640 x 480 pixels; wide-field contact fundus photograph of an infant; acquired on the Clarity RetCam 3
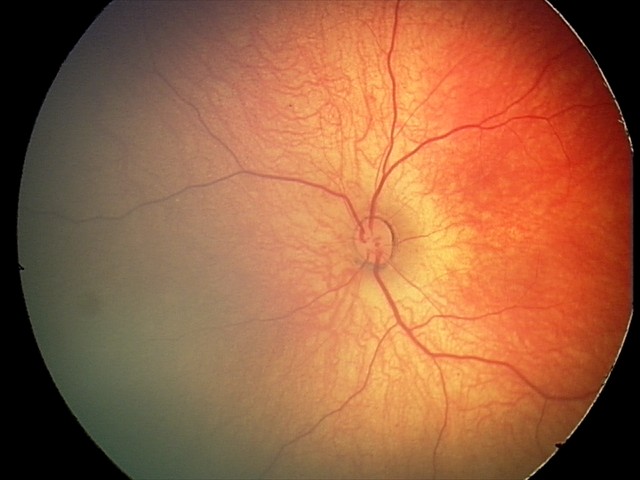
Diagnosis = retinal hemorrhages